FOV: 45 degrees
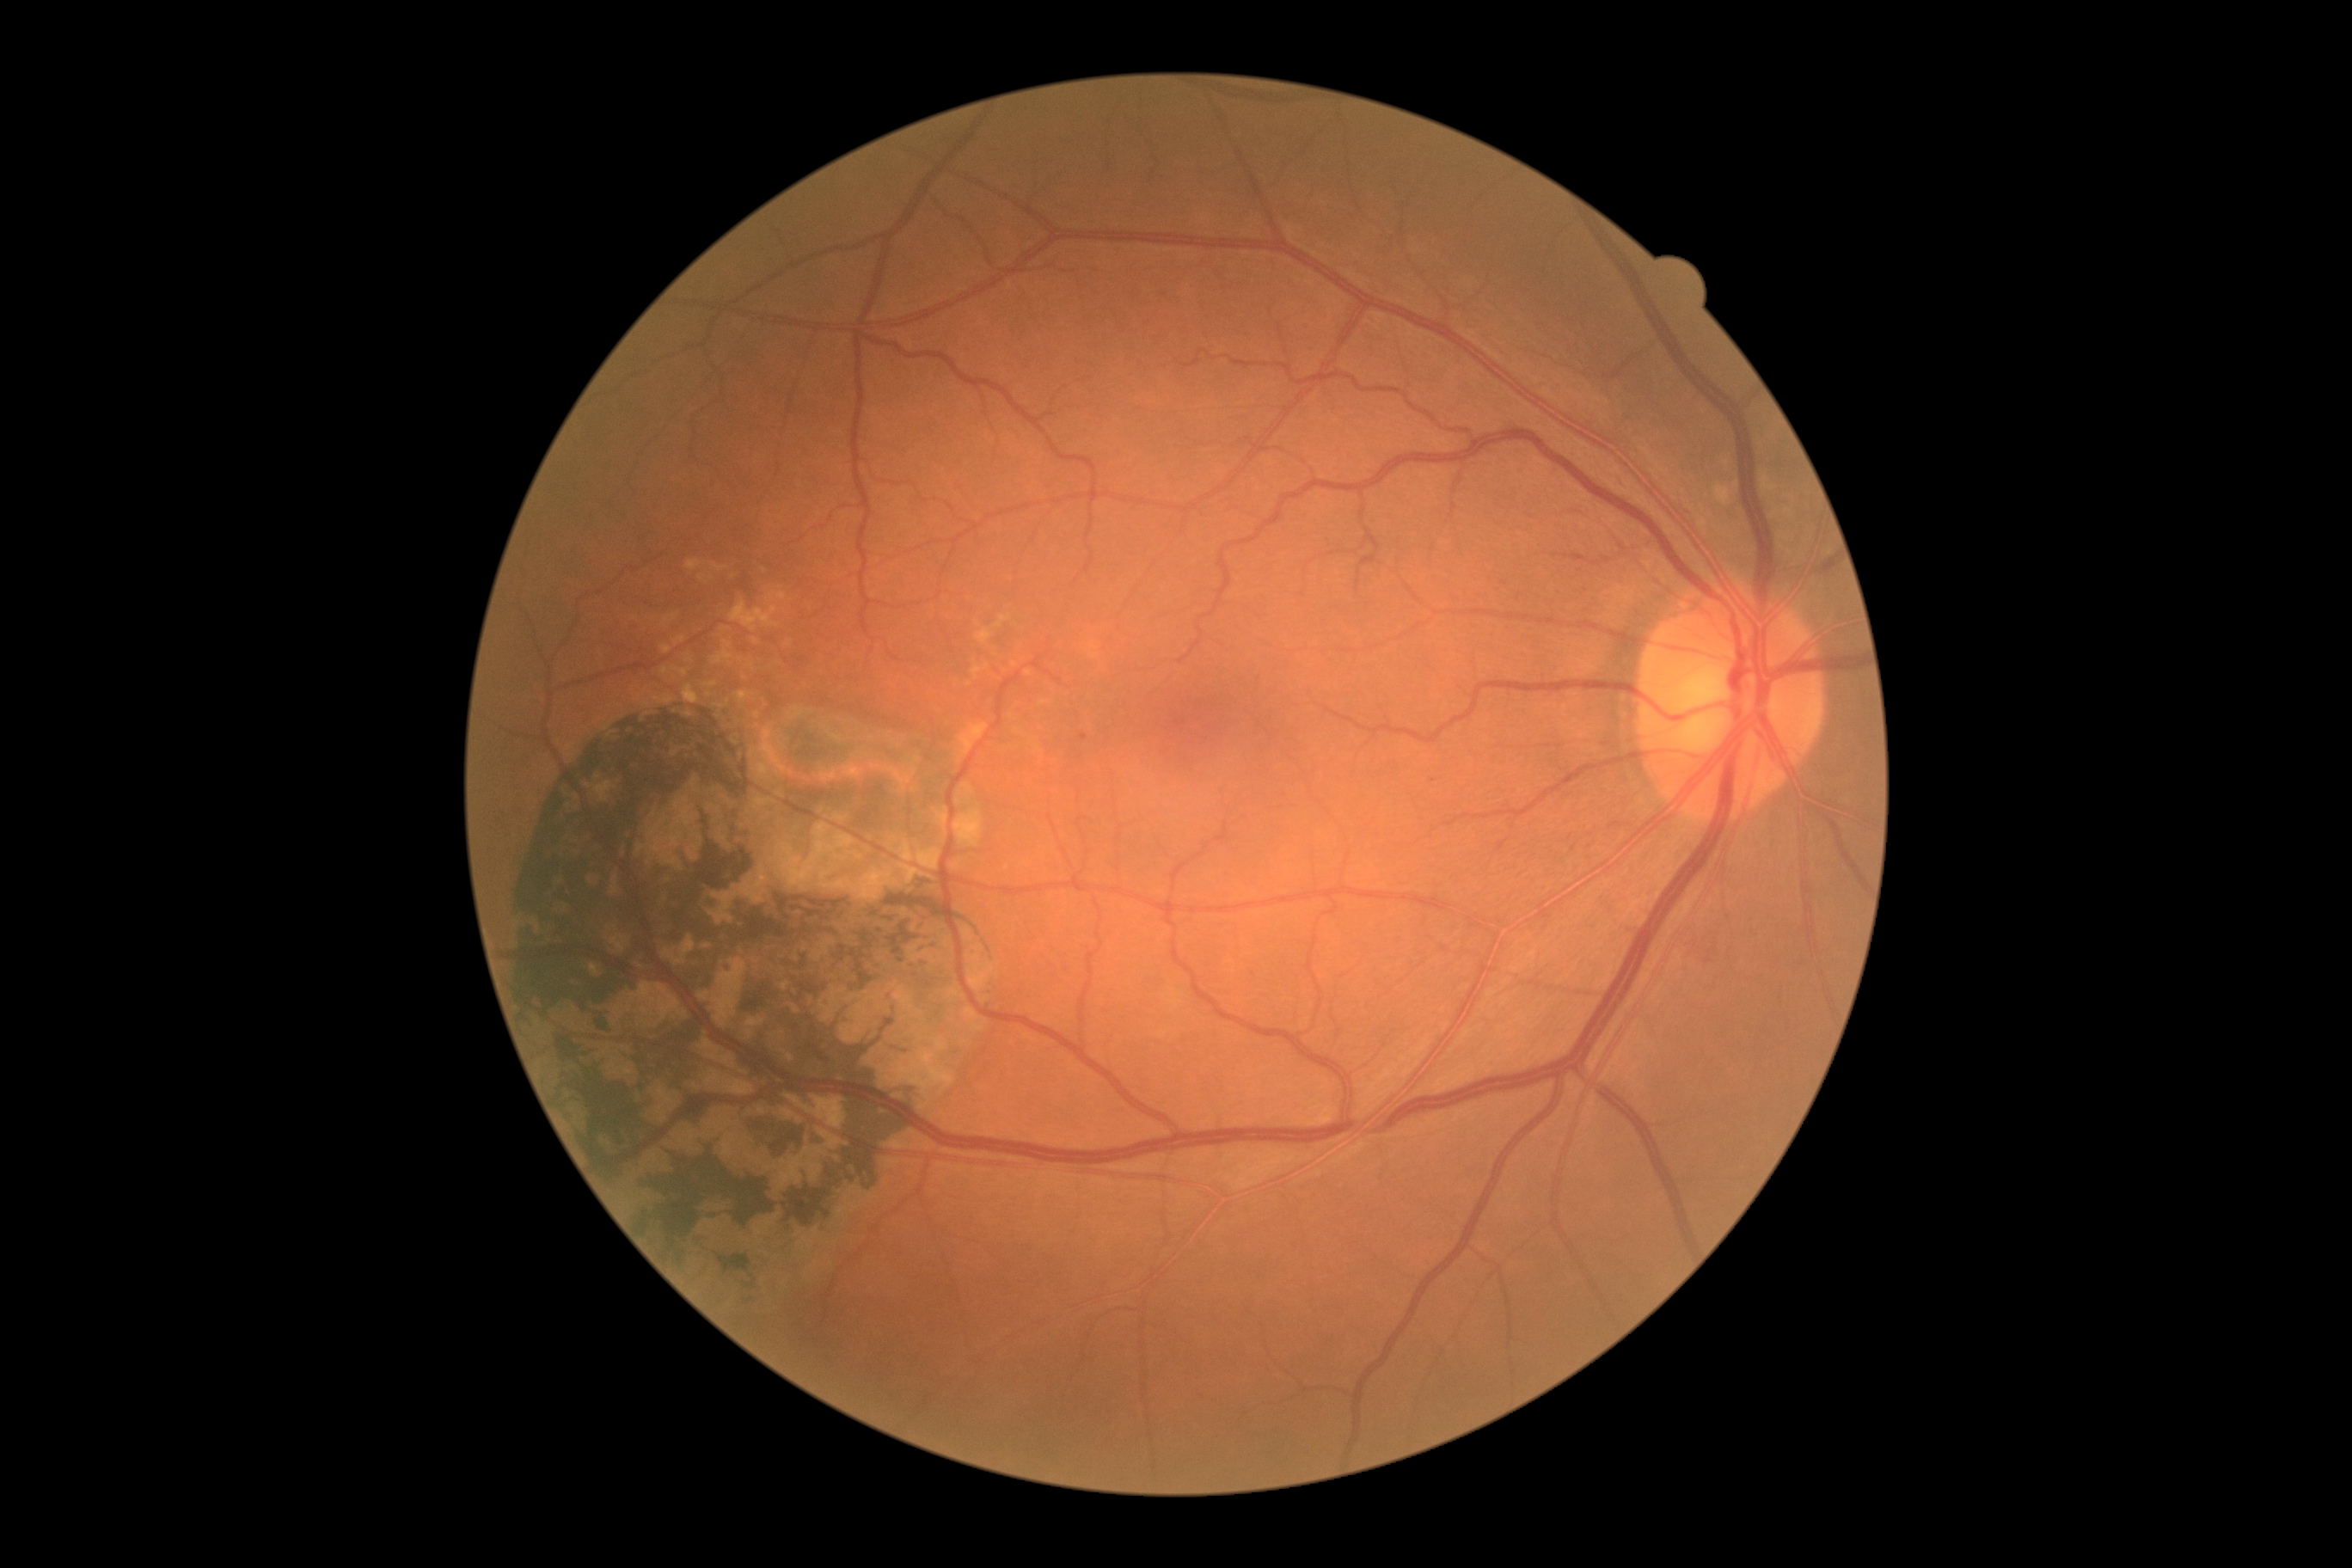

Retinopathy: grade 1 (mild NPDR).